130° field of view (Natus RetCam Envision) · wide-field fundus photograph from neonatal ROP screening · 1440 x 1080 pixels — 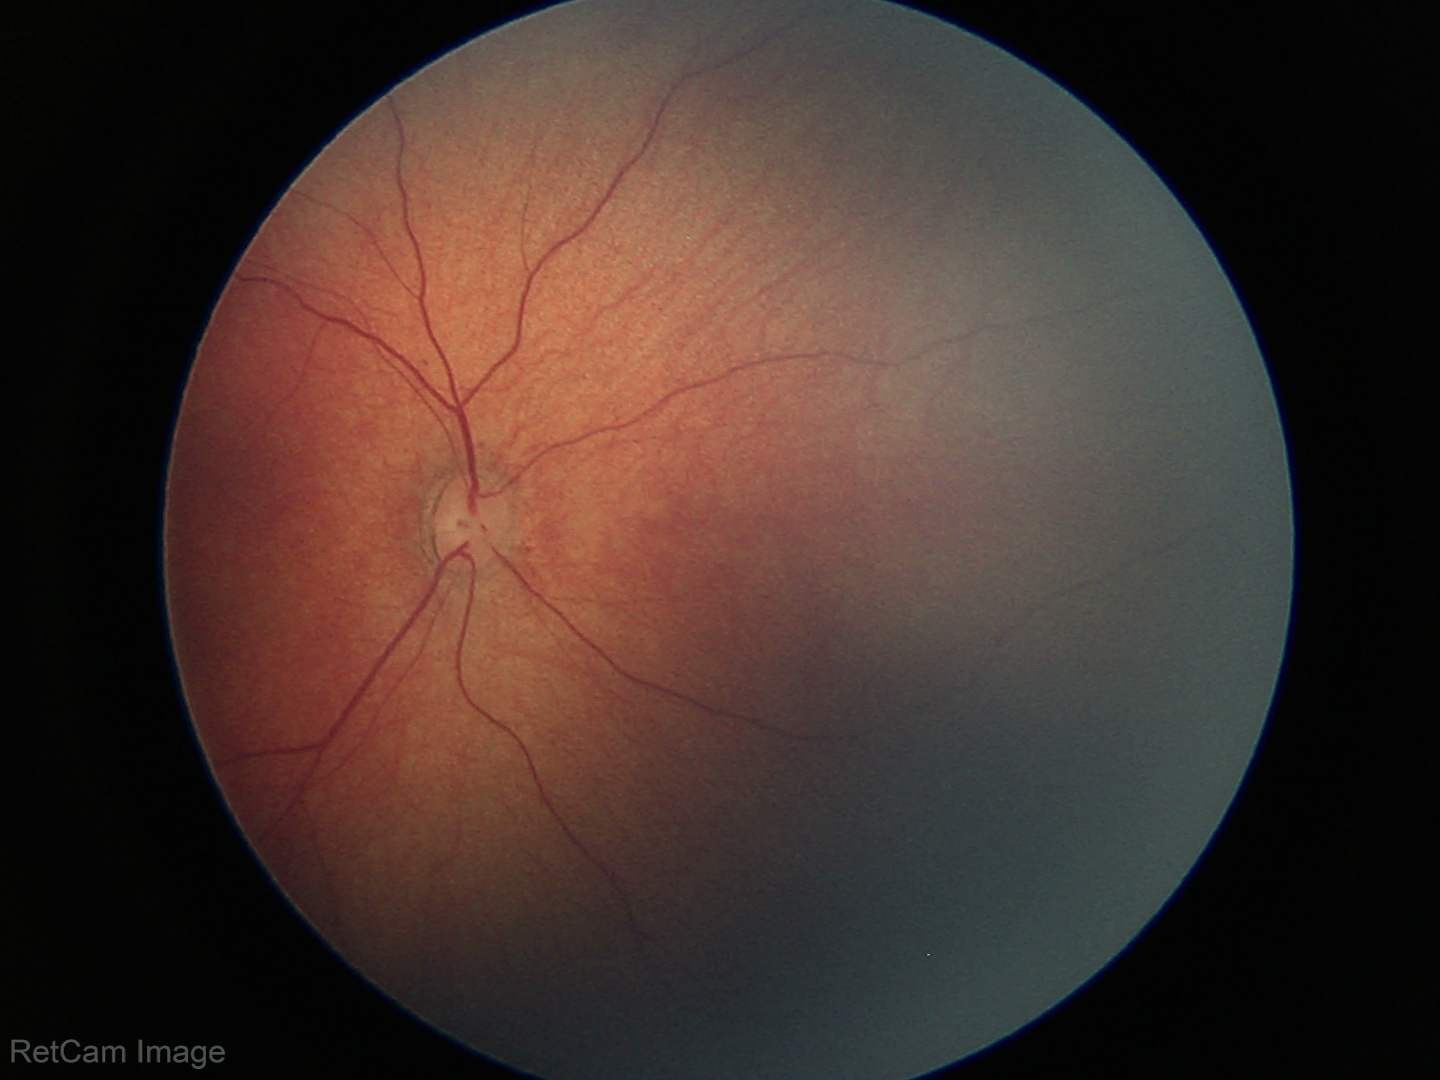 Physiological retinal appearance for postconceptual age.